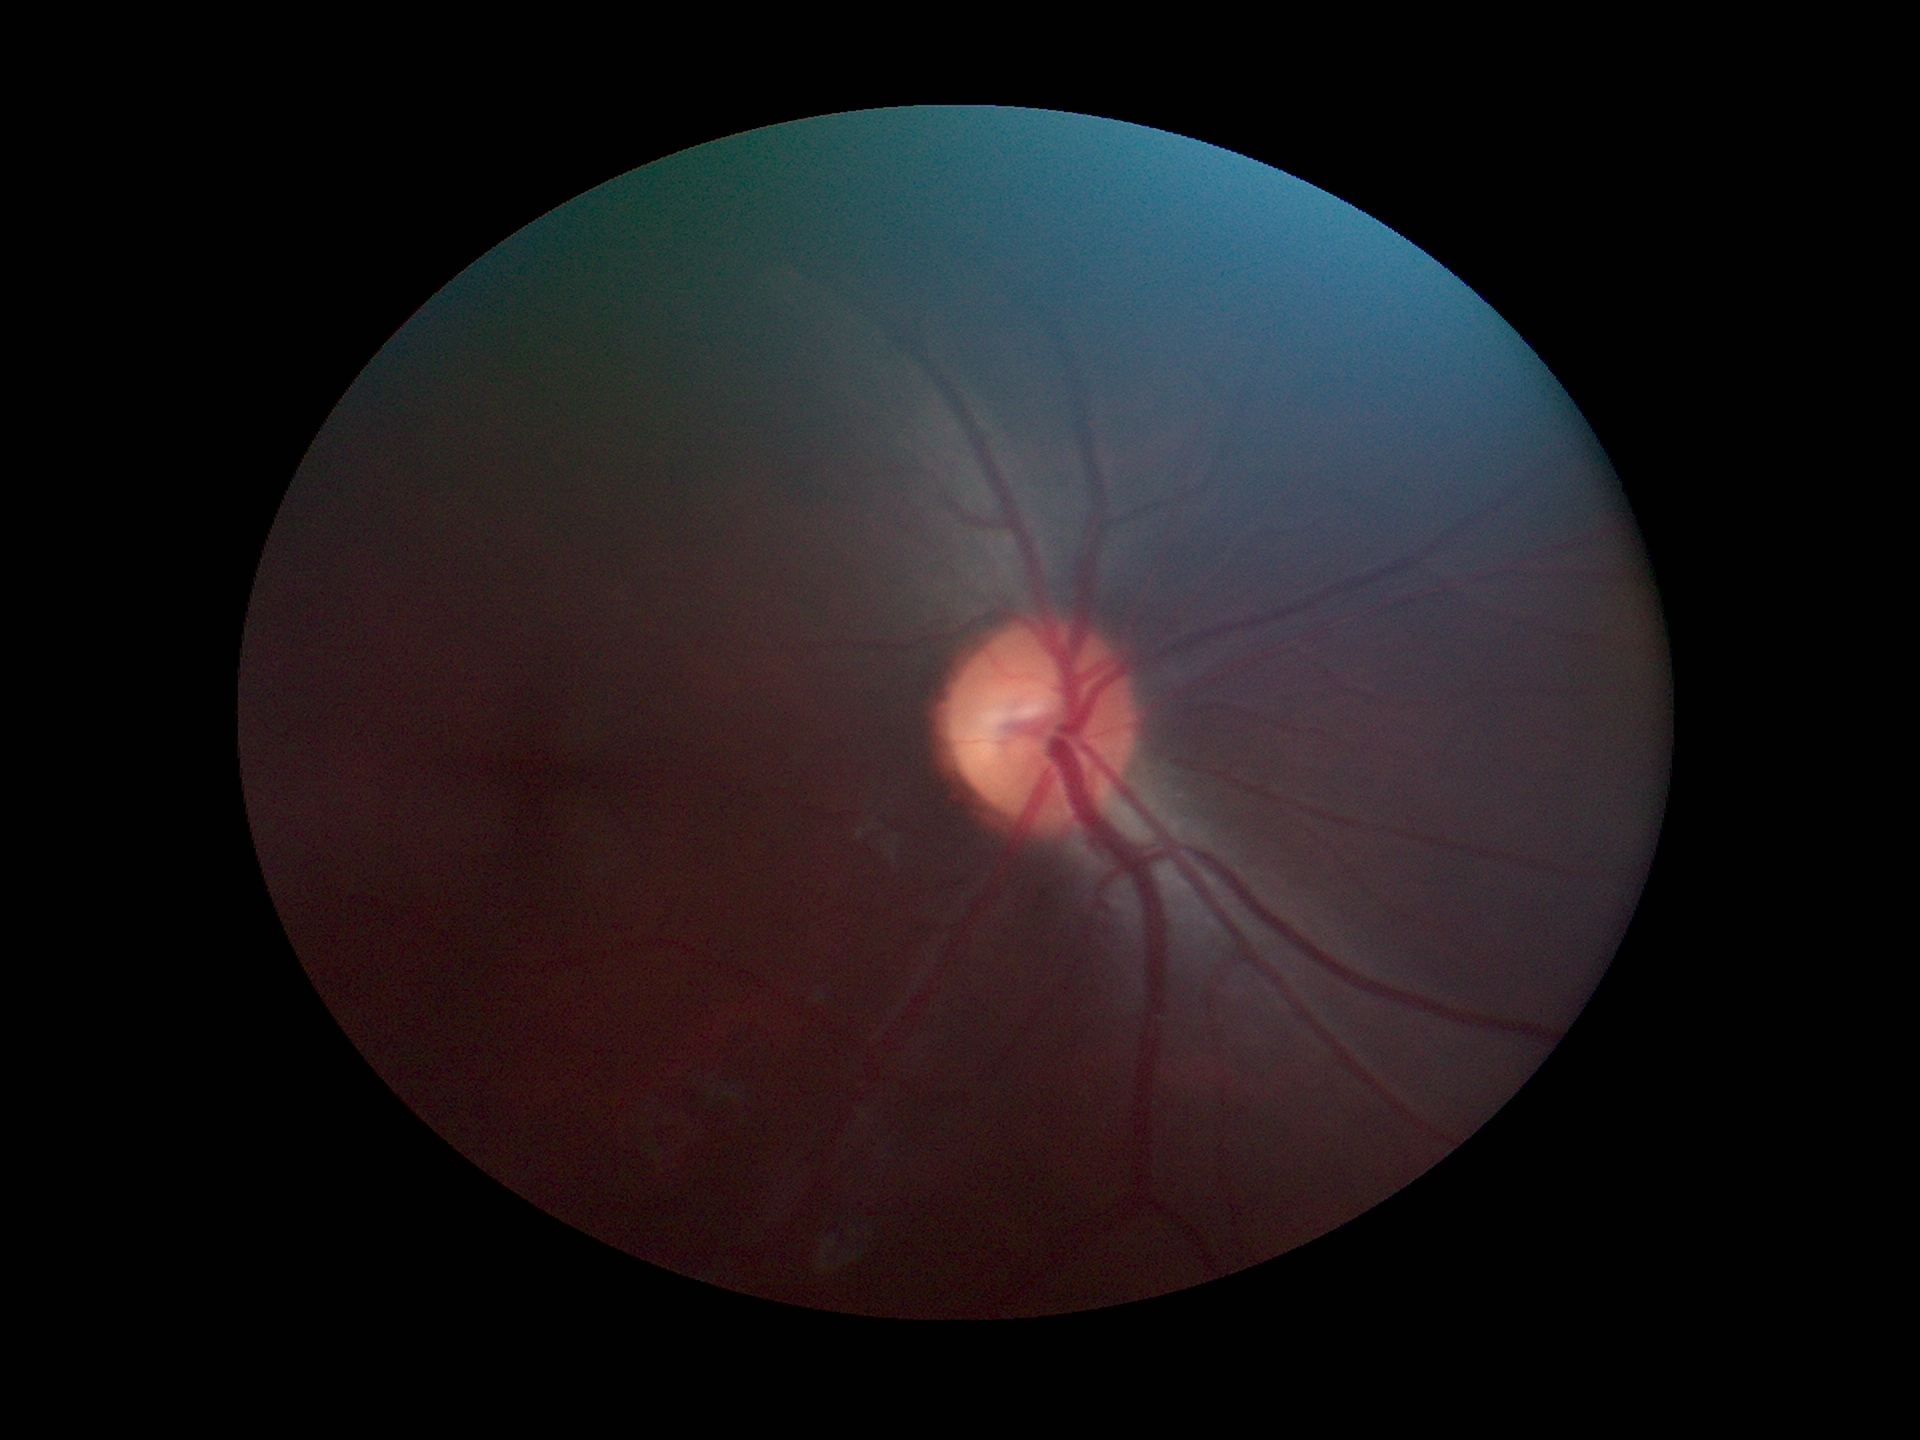
Glaucoma assessment: not suspect. Vertical cup-disc ratio is 0.49. Horizontal cup-disc ratio: 0.51.